1380 x 1382 pixels · fundus photo:
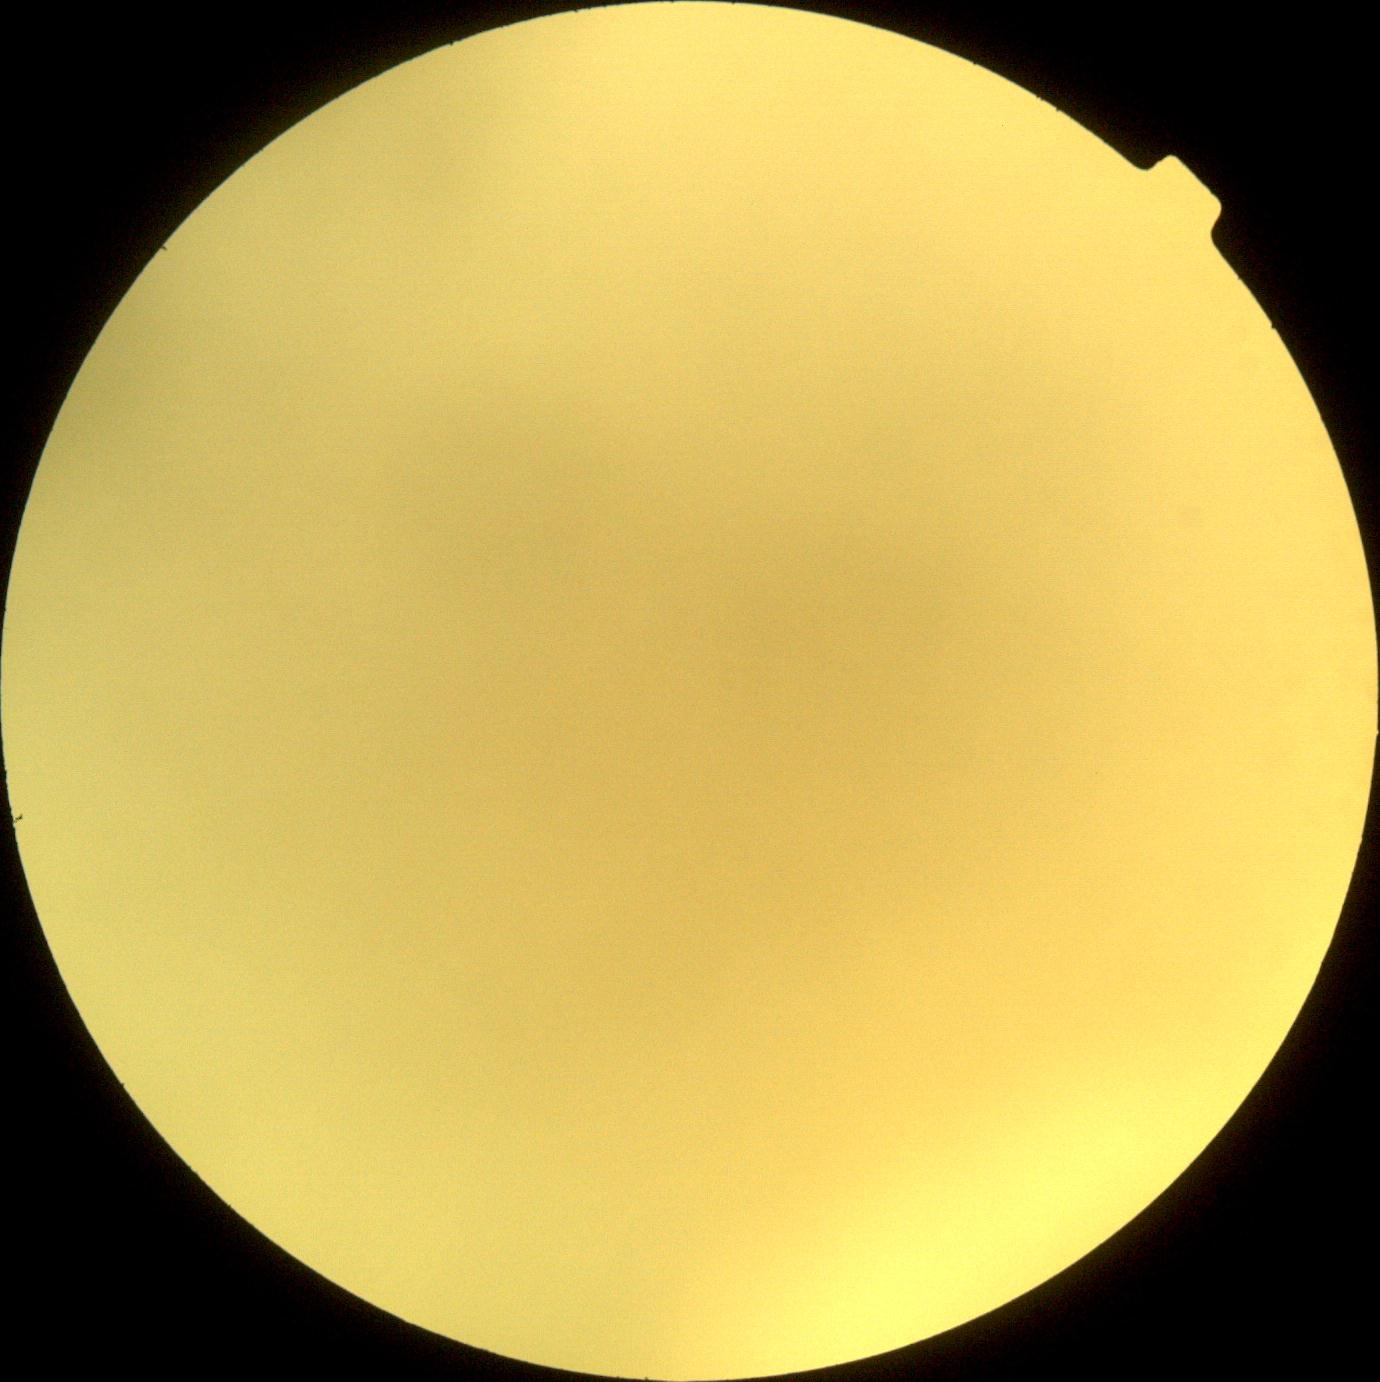 DR stage is ungradable due to poor image quality. Image quality is insufficient for diabetic retinopathy assessment.